2048 x 1536 pixels; color fundus photograph
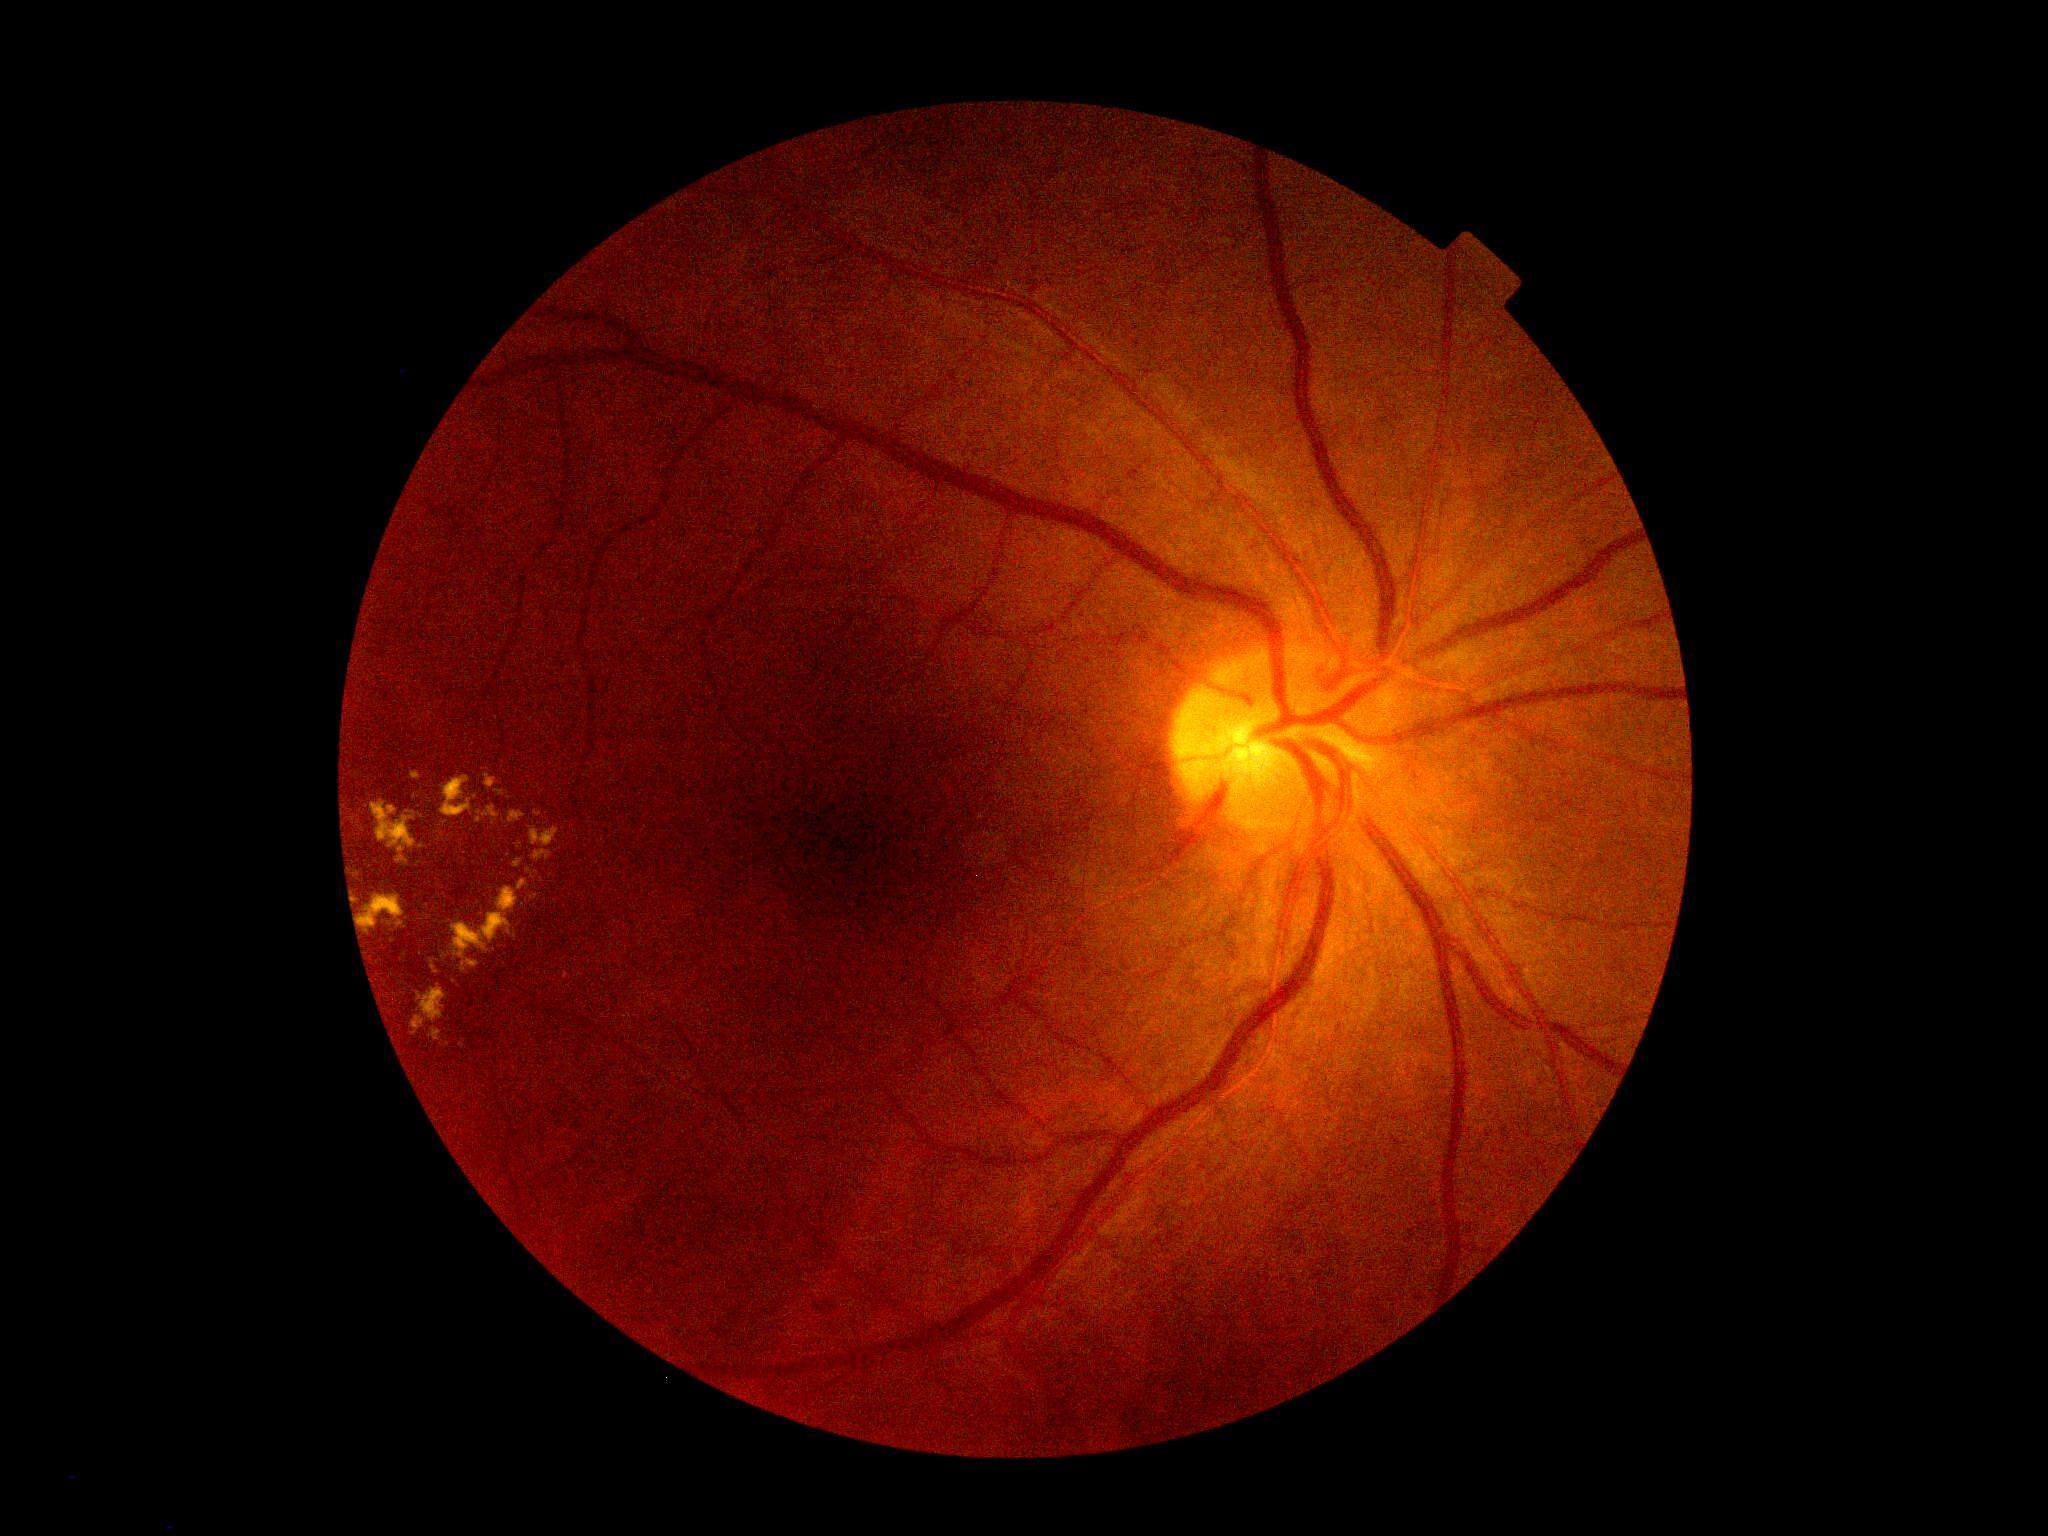
diabetic retinopathy = grade 2 (moderate NPDR).